45° FOV — 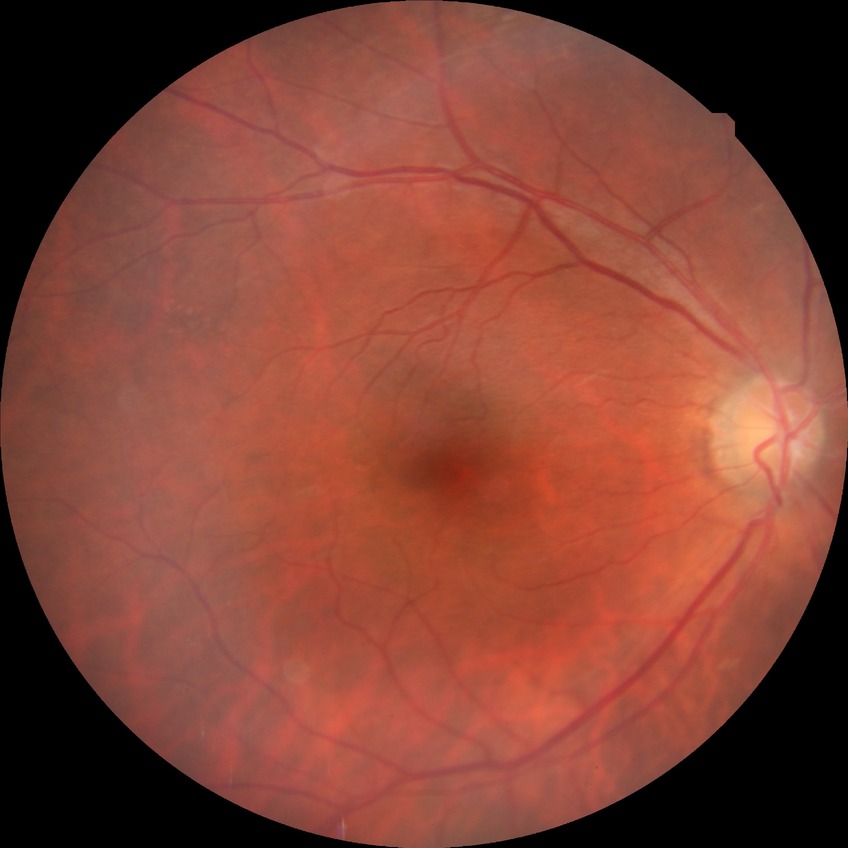 Diabetic retinopathy (DR): NDR (no diabetic retinopathy).